Camera: Clarity RetCam 3 (130° FOV); image size 640x480; infant wide-field retinal image
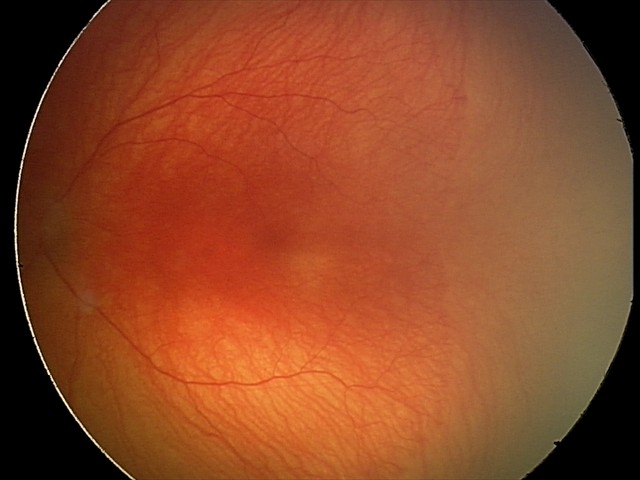 Diagnosis from this screening exam: aggressive retinopathy of prematurity (A-ROP).